Bosch handheld fundus camera
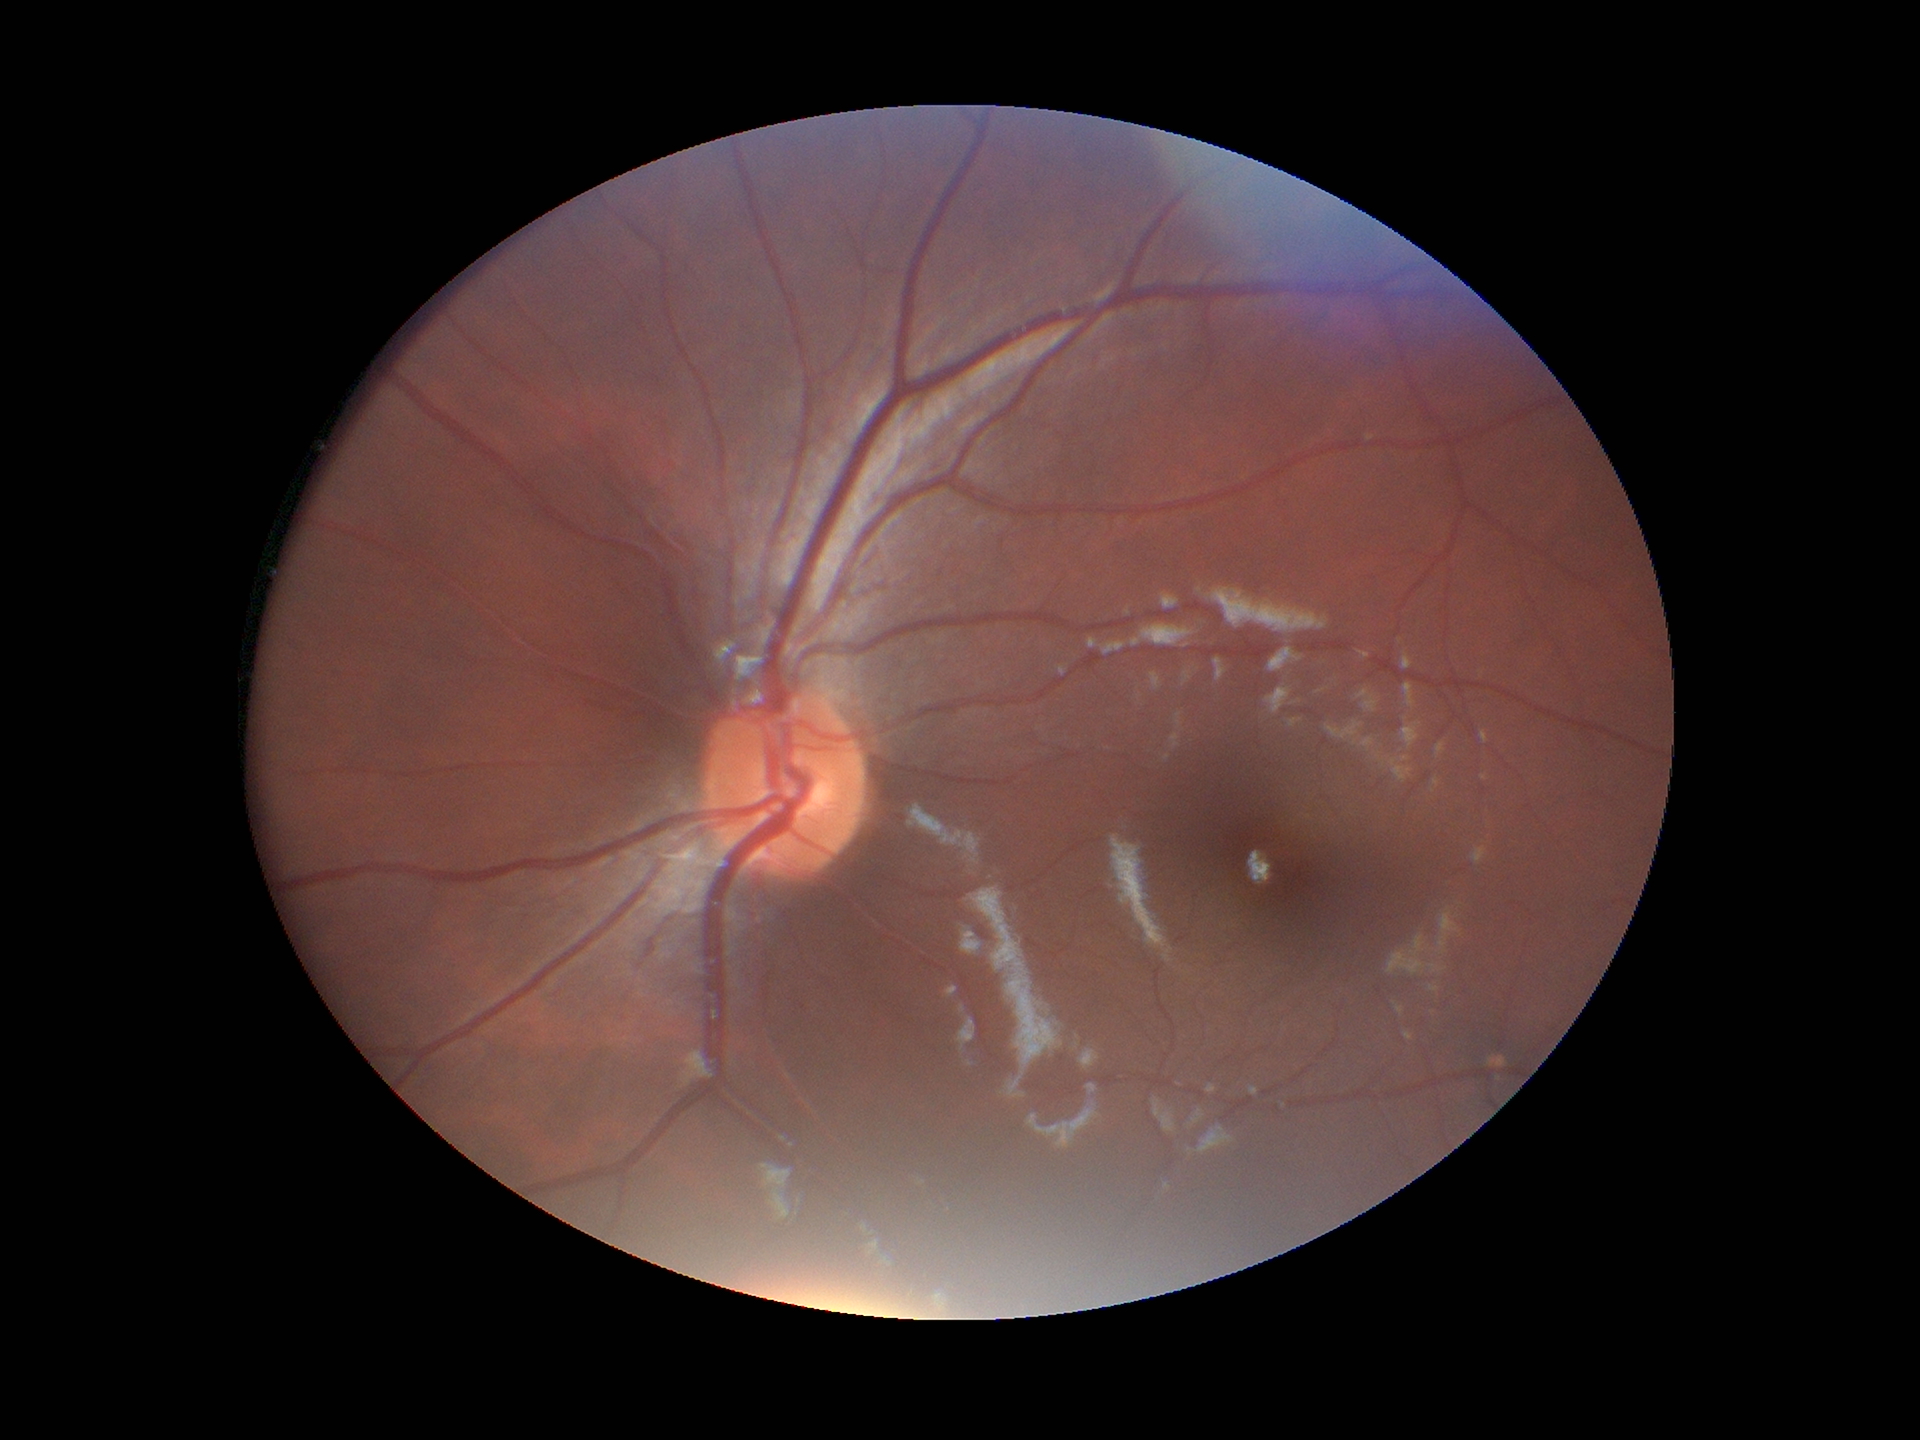 Glaucoma screening impression = negative
horizontal cup-to-disc ratio = 0.49
vertical cup-to-disc ratio = 0.42